45-degree field of view.
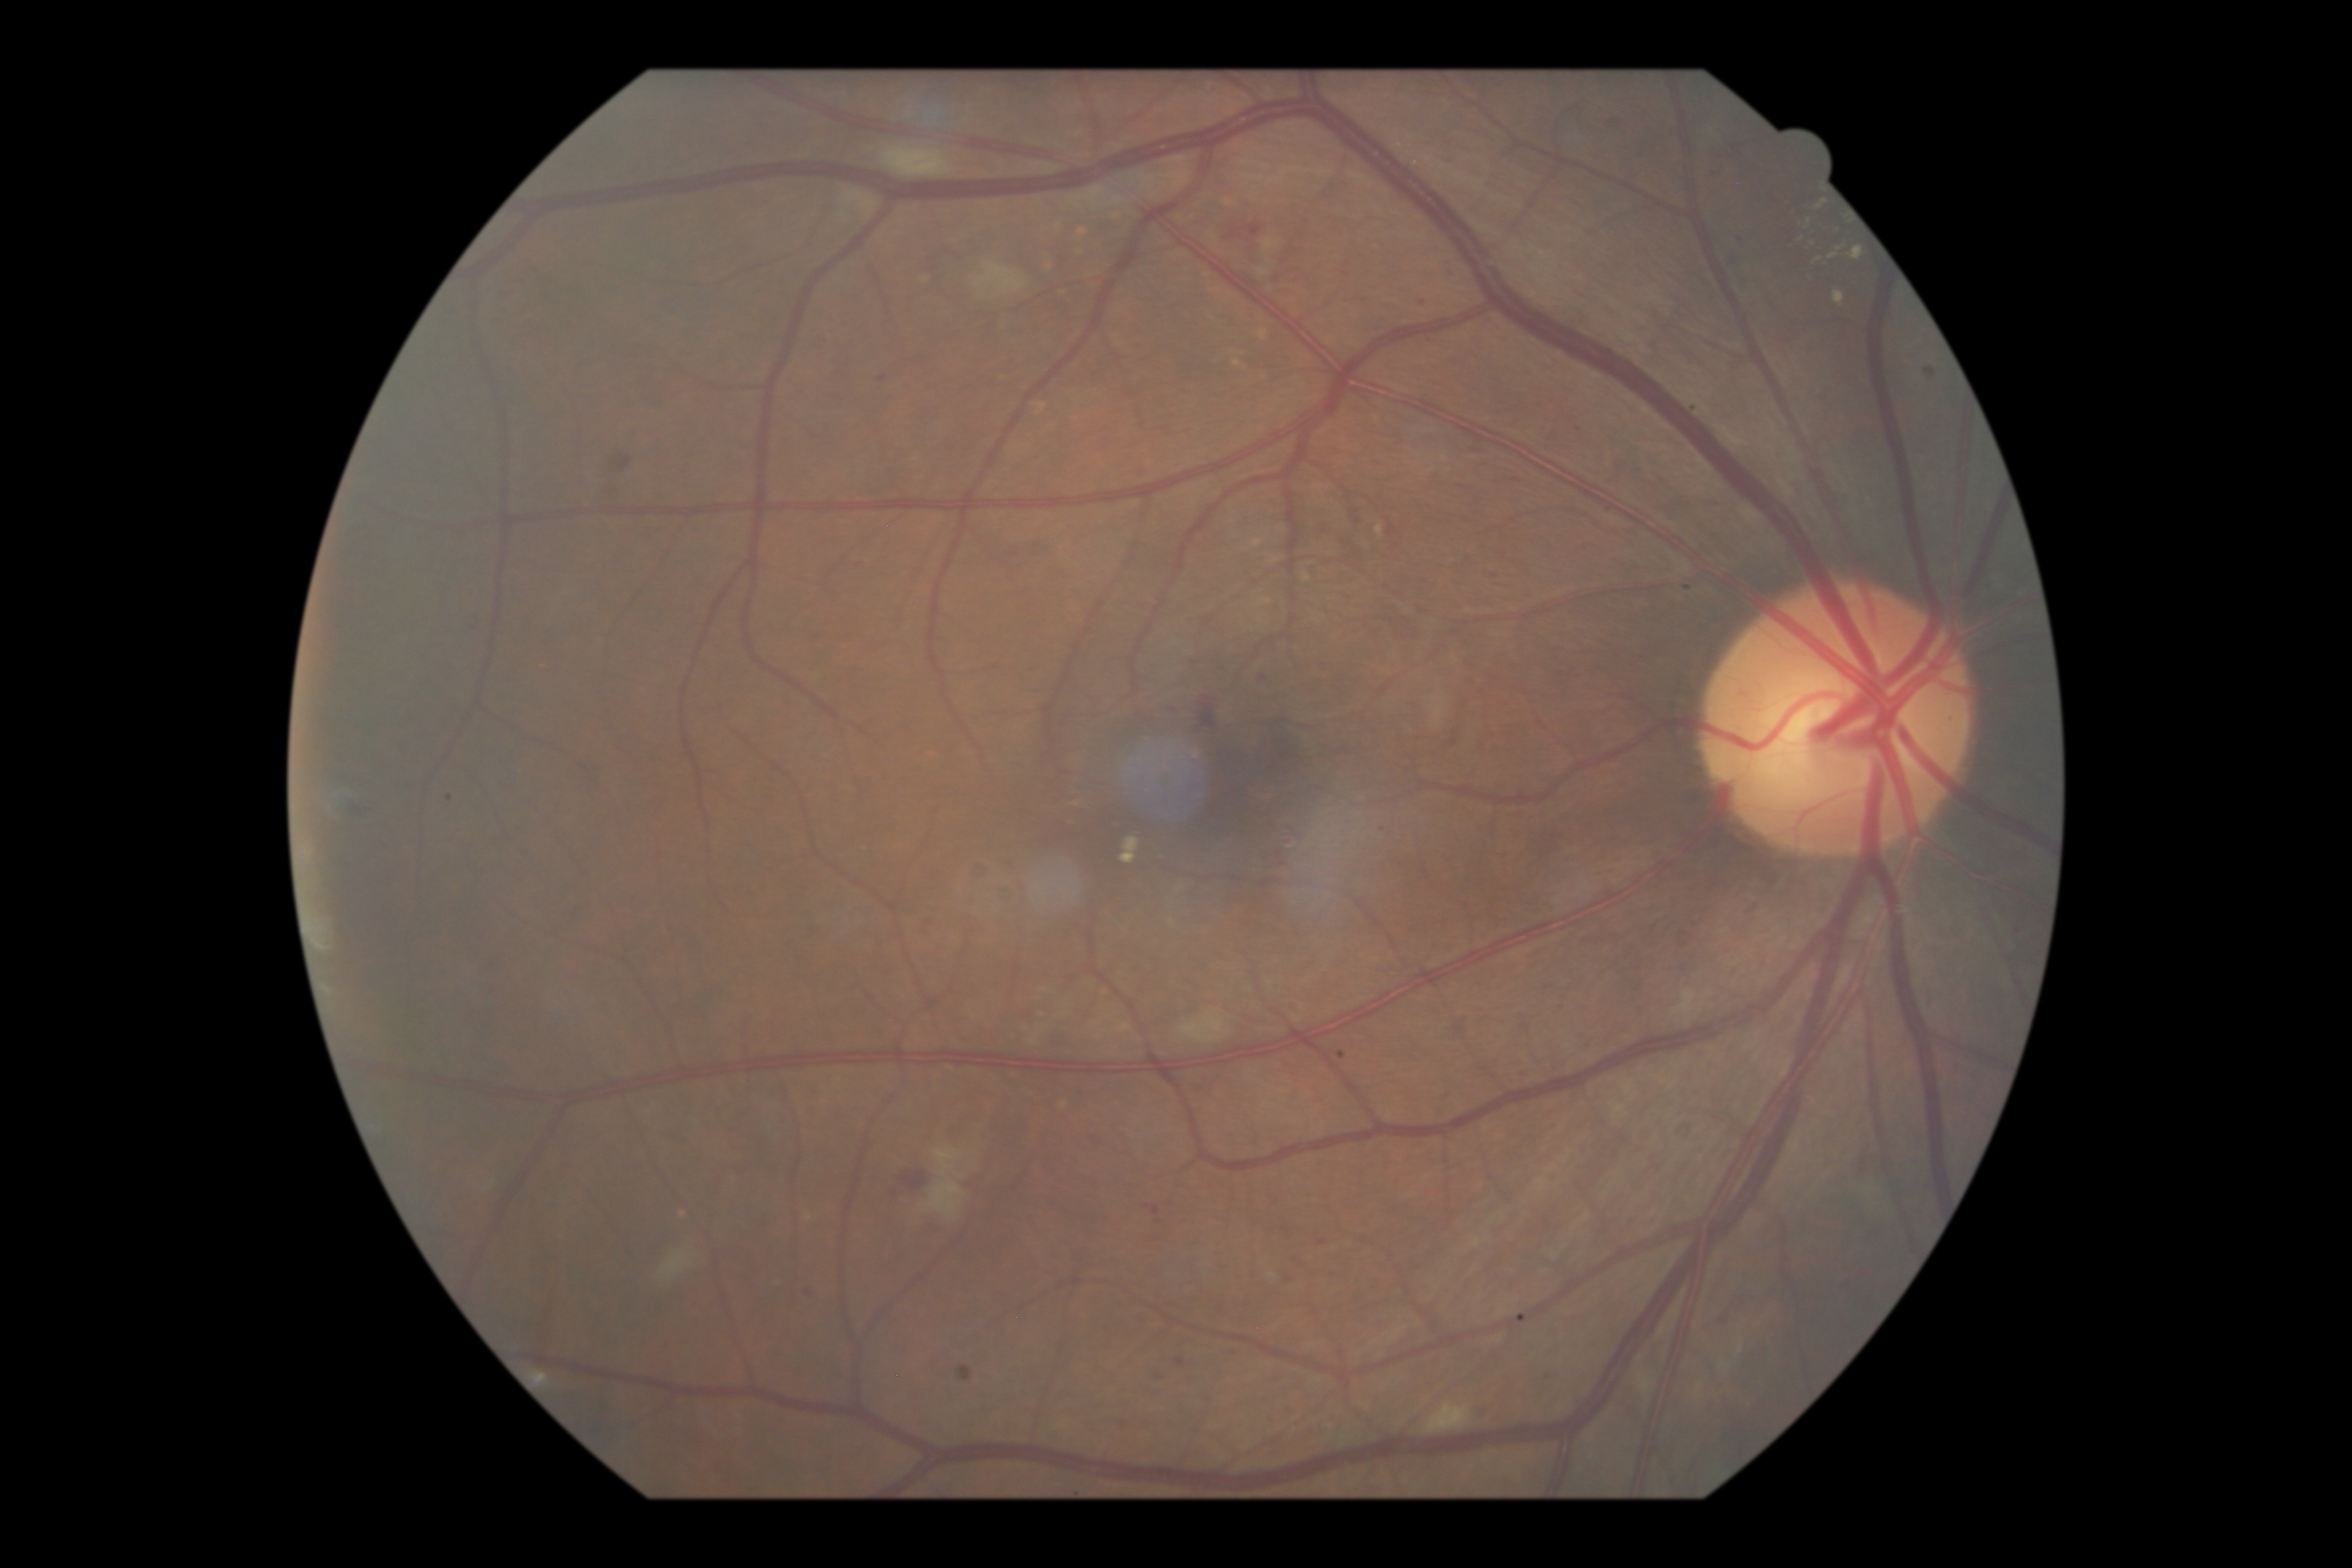

{"dr_grade": "grade 2 (moderate NPDR)"}